45-degree field of view, 2352x1568px: 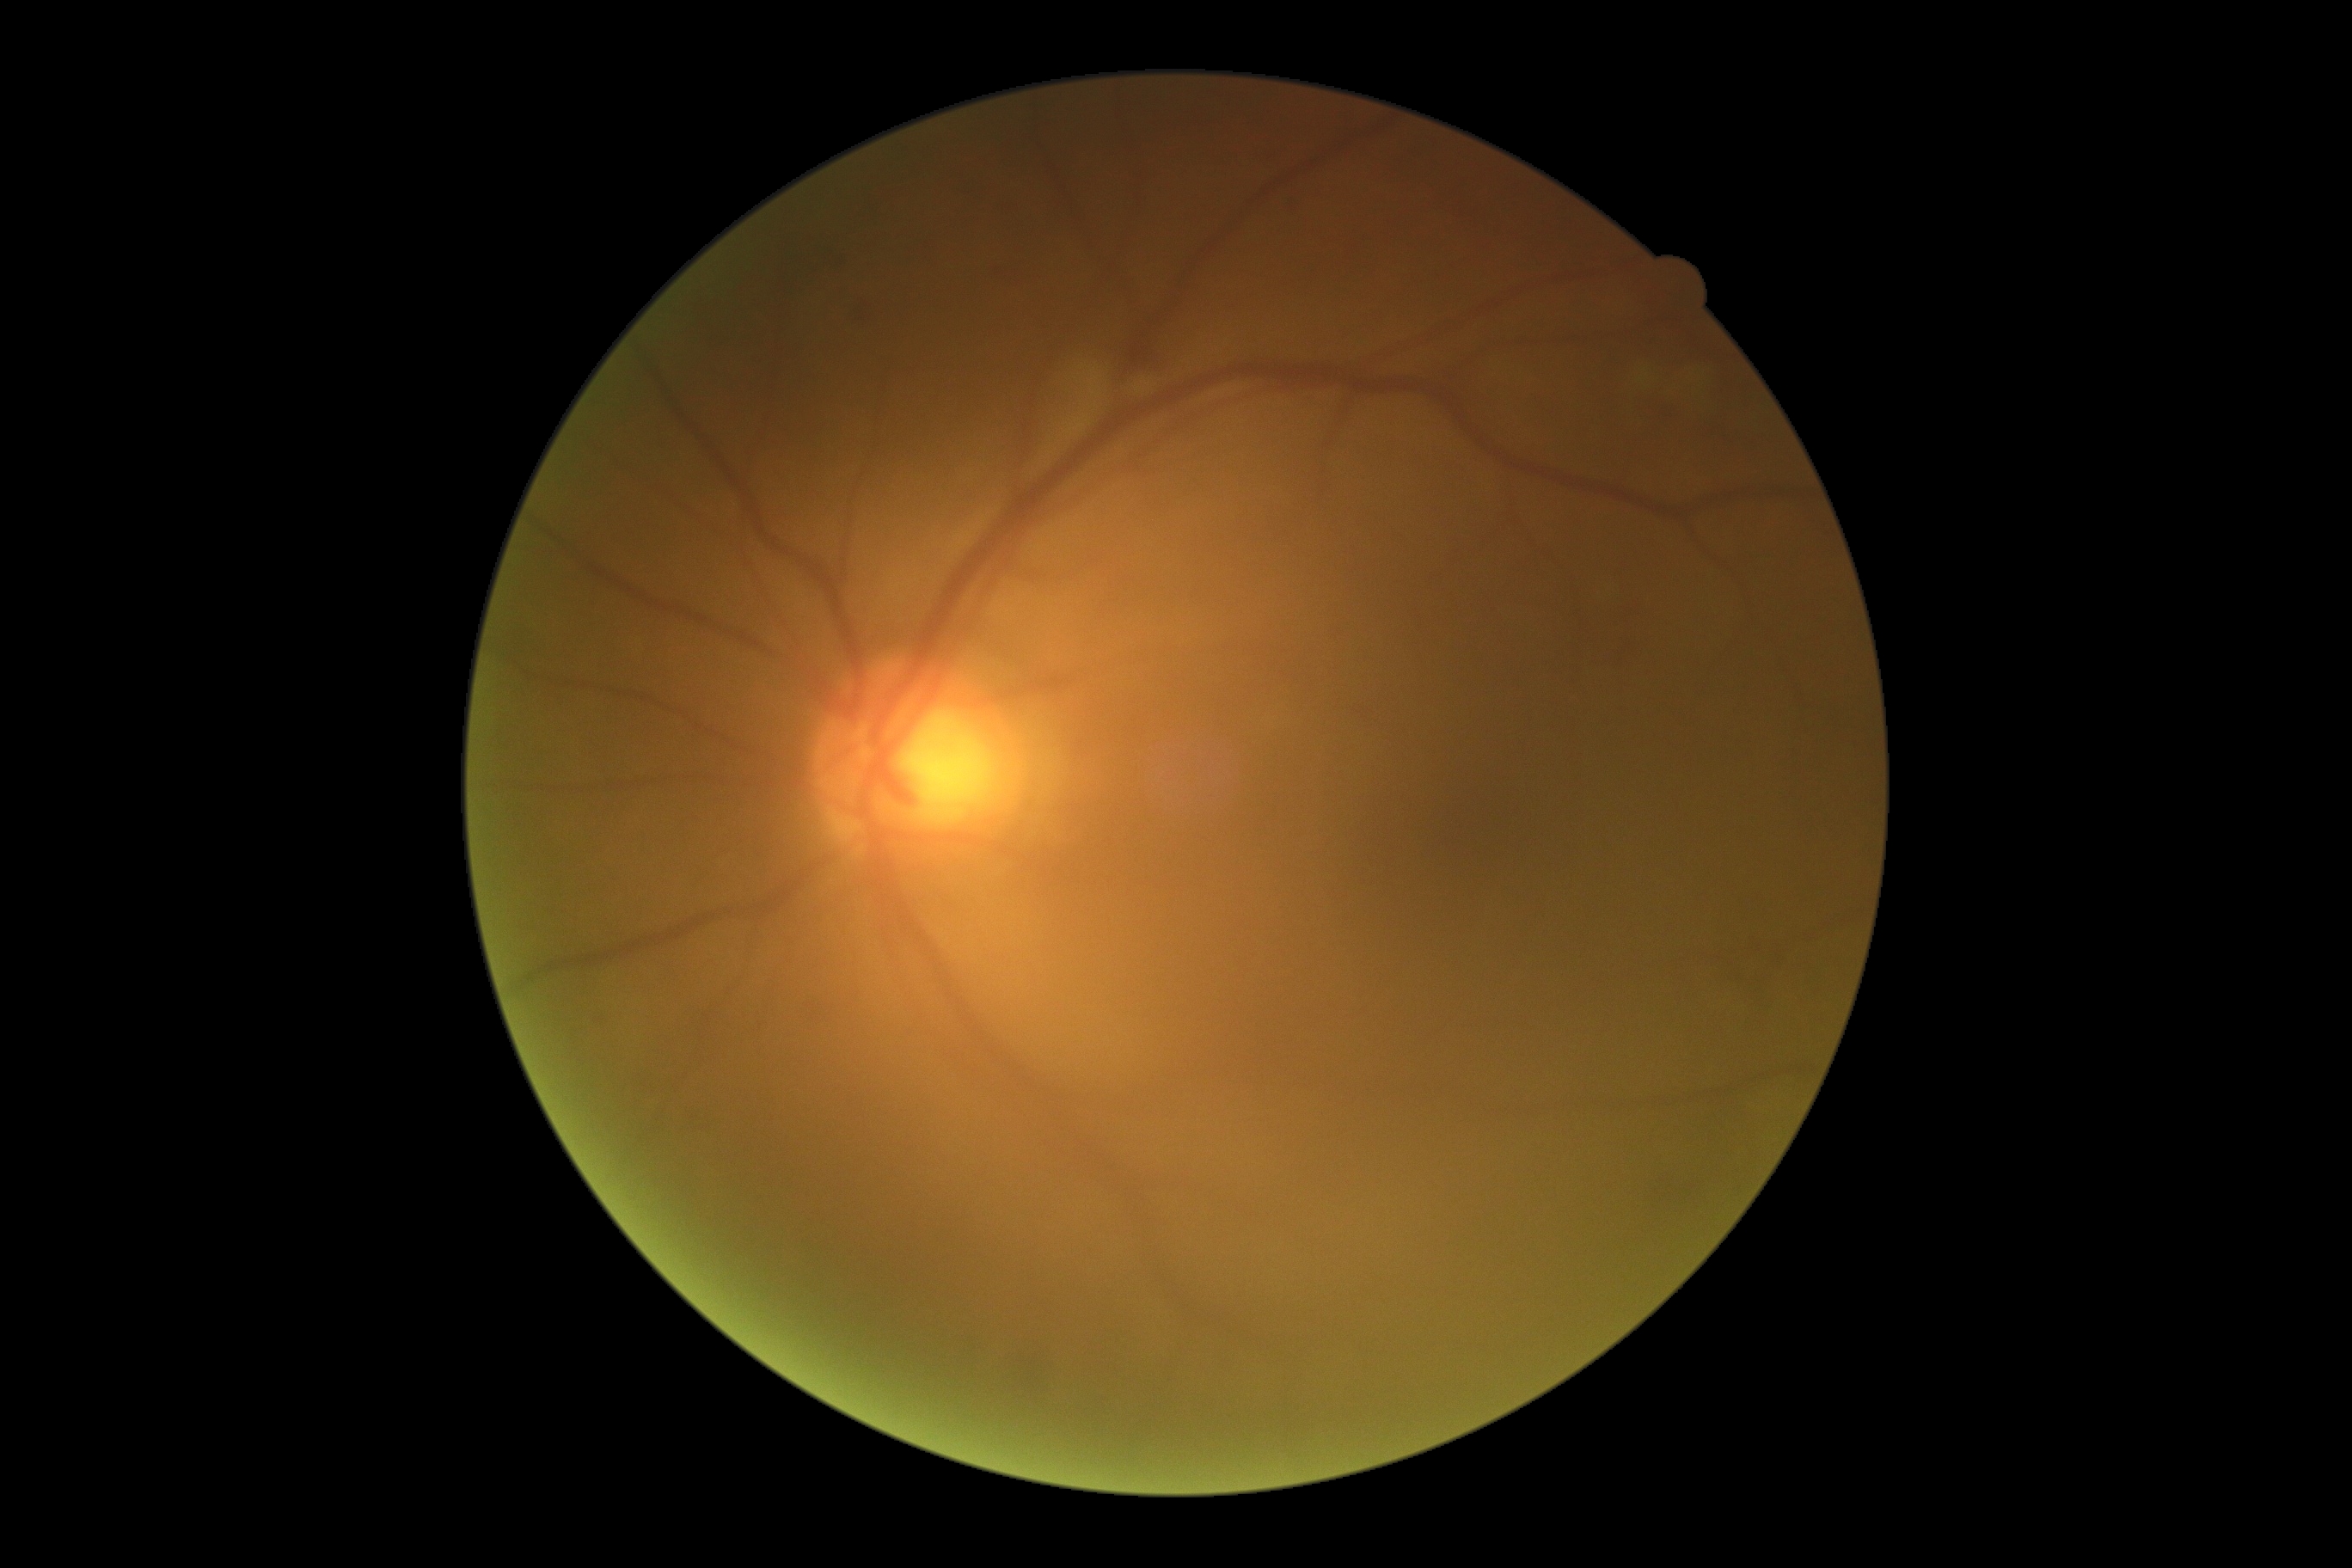

Retinopathy grade: 2/4.